DR severity per modified Davis staging · nonmydriatic fundus photograph · posterior pole photograph.
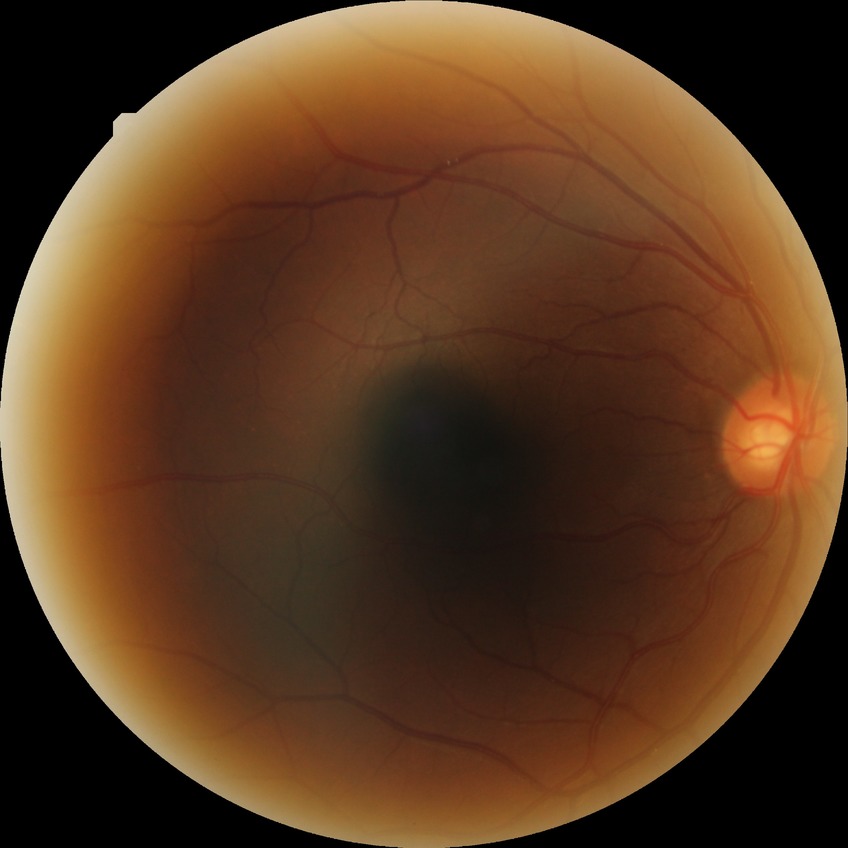
{"davis_grade": "no diabetic retinopathy"}